Nonmydriatic fundus photograph. NIDEK AFC-230. Color fundus image. 45° FOV:
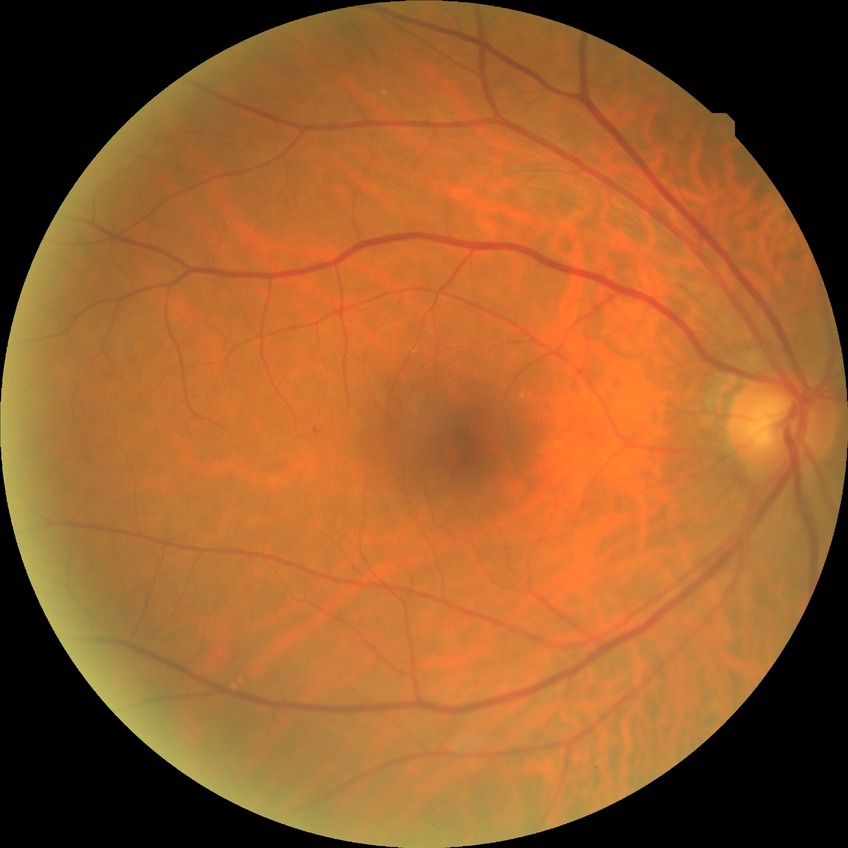

davis_grade: simple diabetic retinopathy (SDR)